640x480px. Wide-field fundus photograph of an infant. Clarity RetCam 3, 130° FOV.
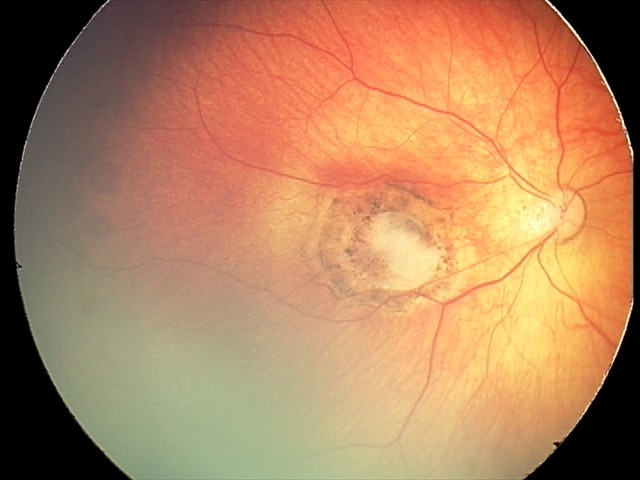
Diagnosis from this screening exam: toxoplasmosis chorioretinitis.